Without pupil dilation; 848 by 848 pixels; DR severity per modified Davis staging.
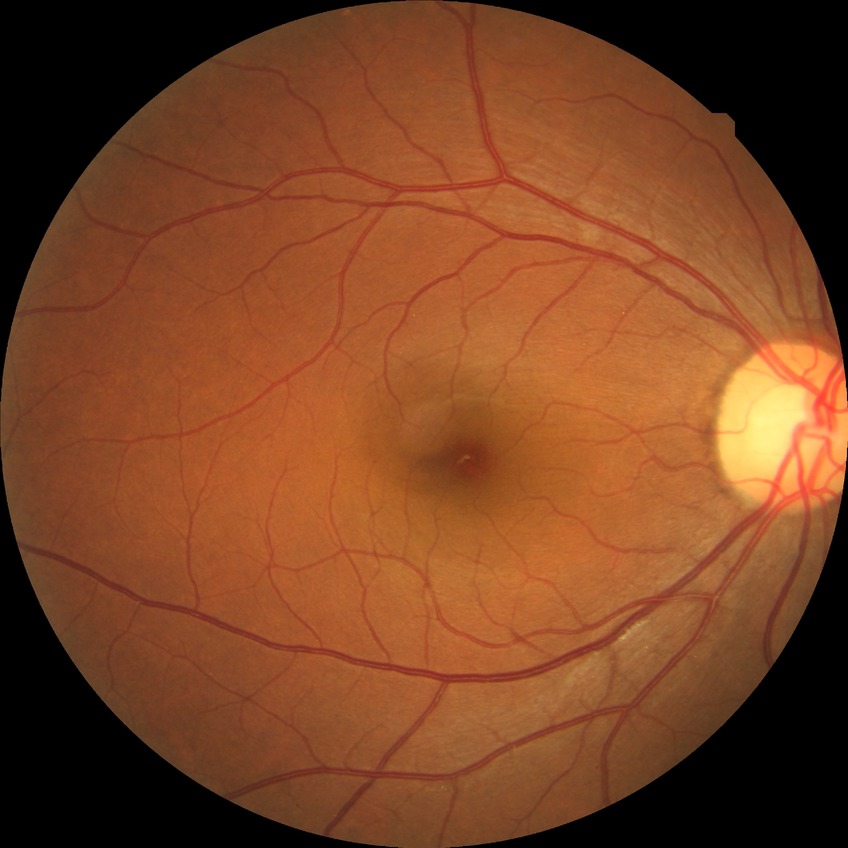 davis_grade: NDR